Camera: NIDEK AFC-230
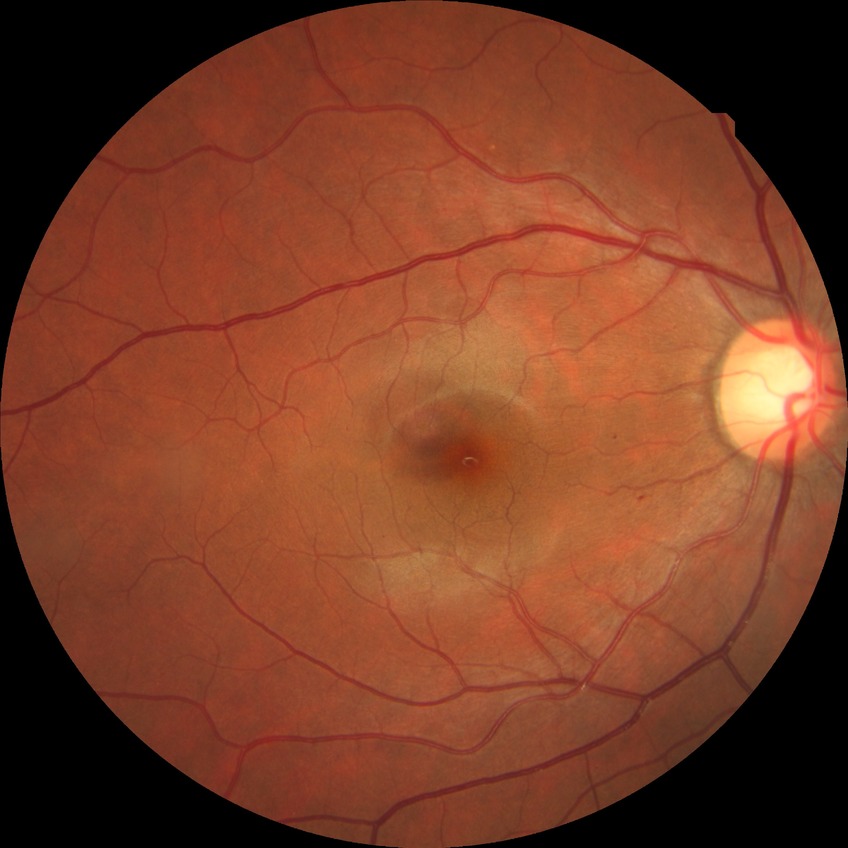
Diabetic retinopathy (DR) is SDR (simple diabetic retinopathy).